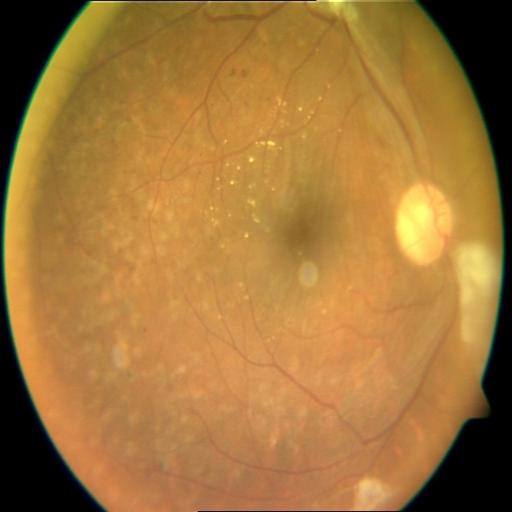

Retinal fundus photograph demonstrating retinitis pigmentosa.